Pediatric retinal photograph (wide-field).
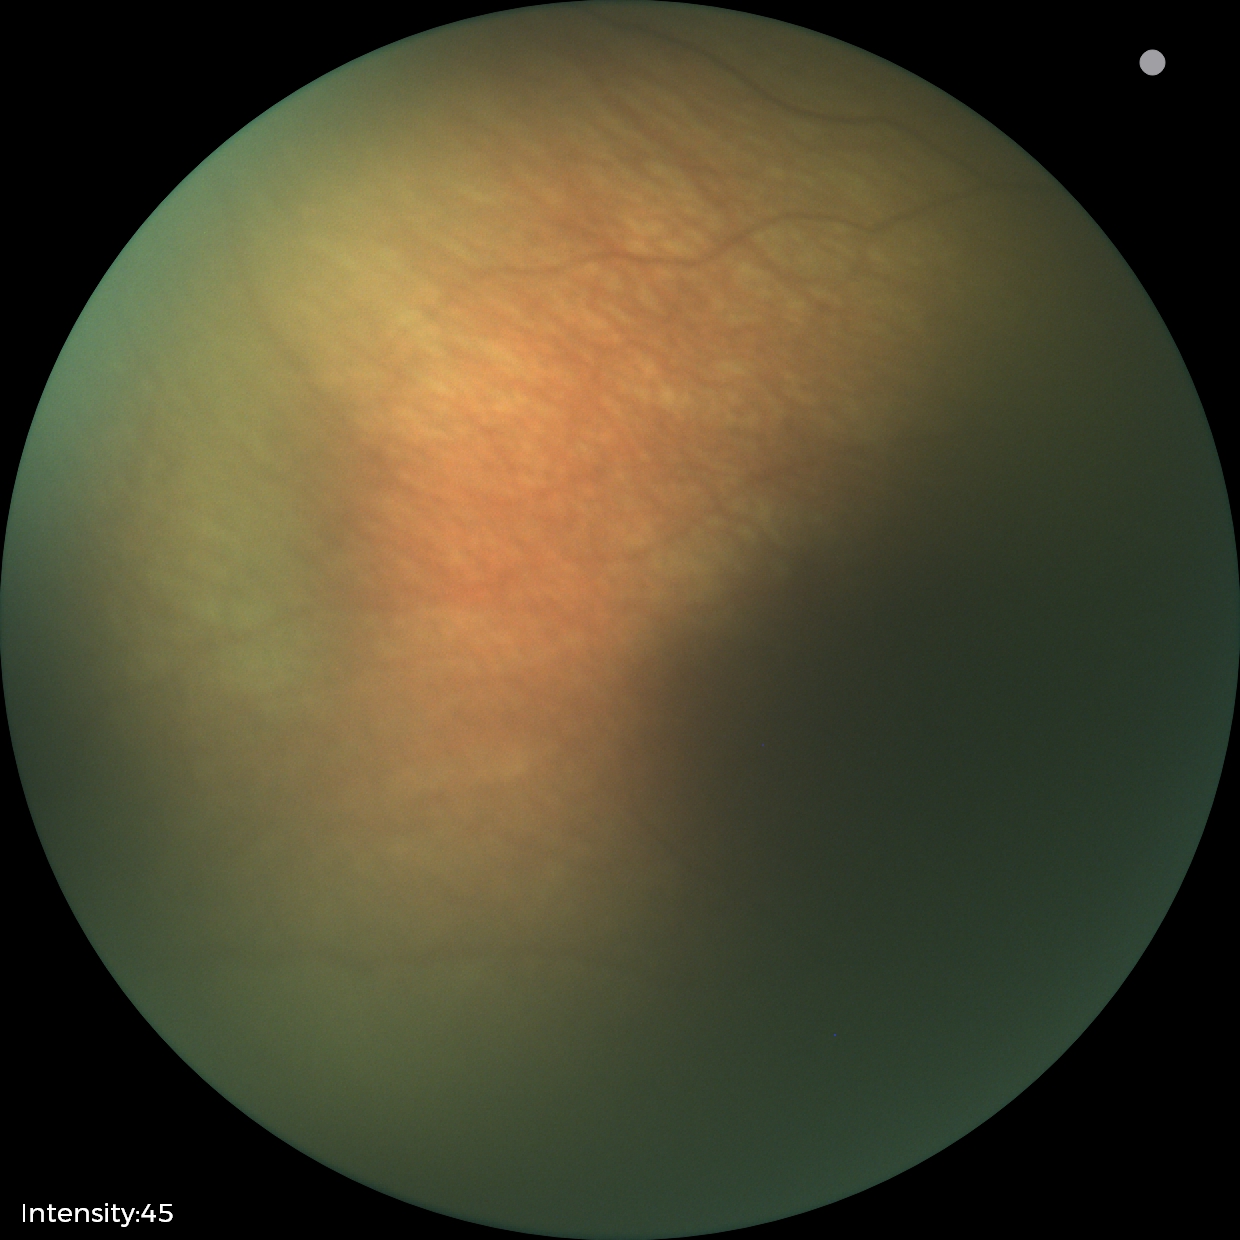

Assessment: normal retinal appearance.